Color fundus image
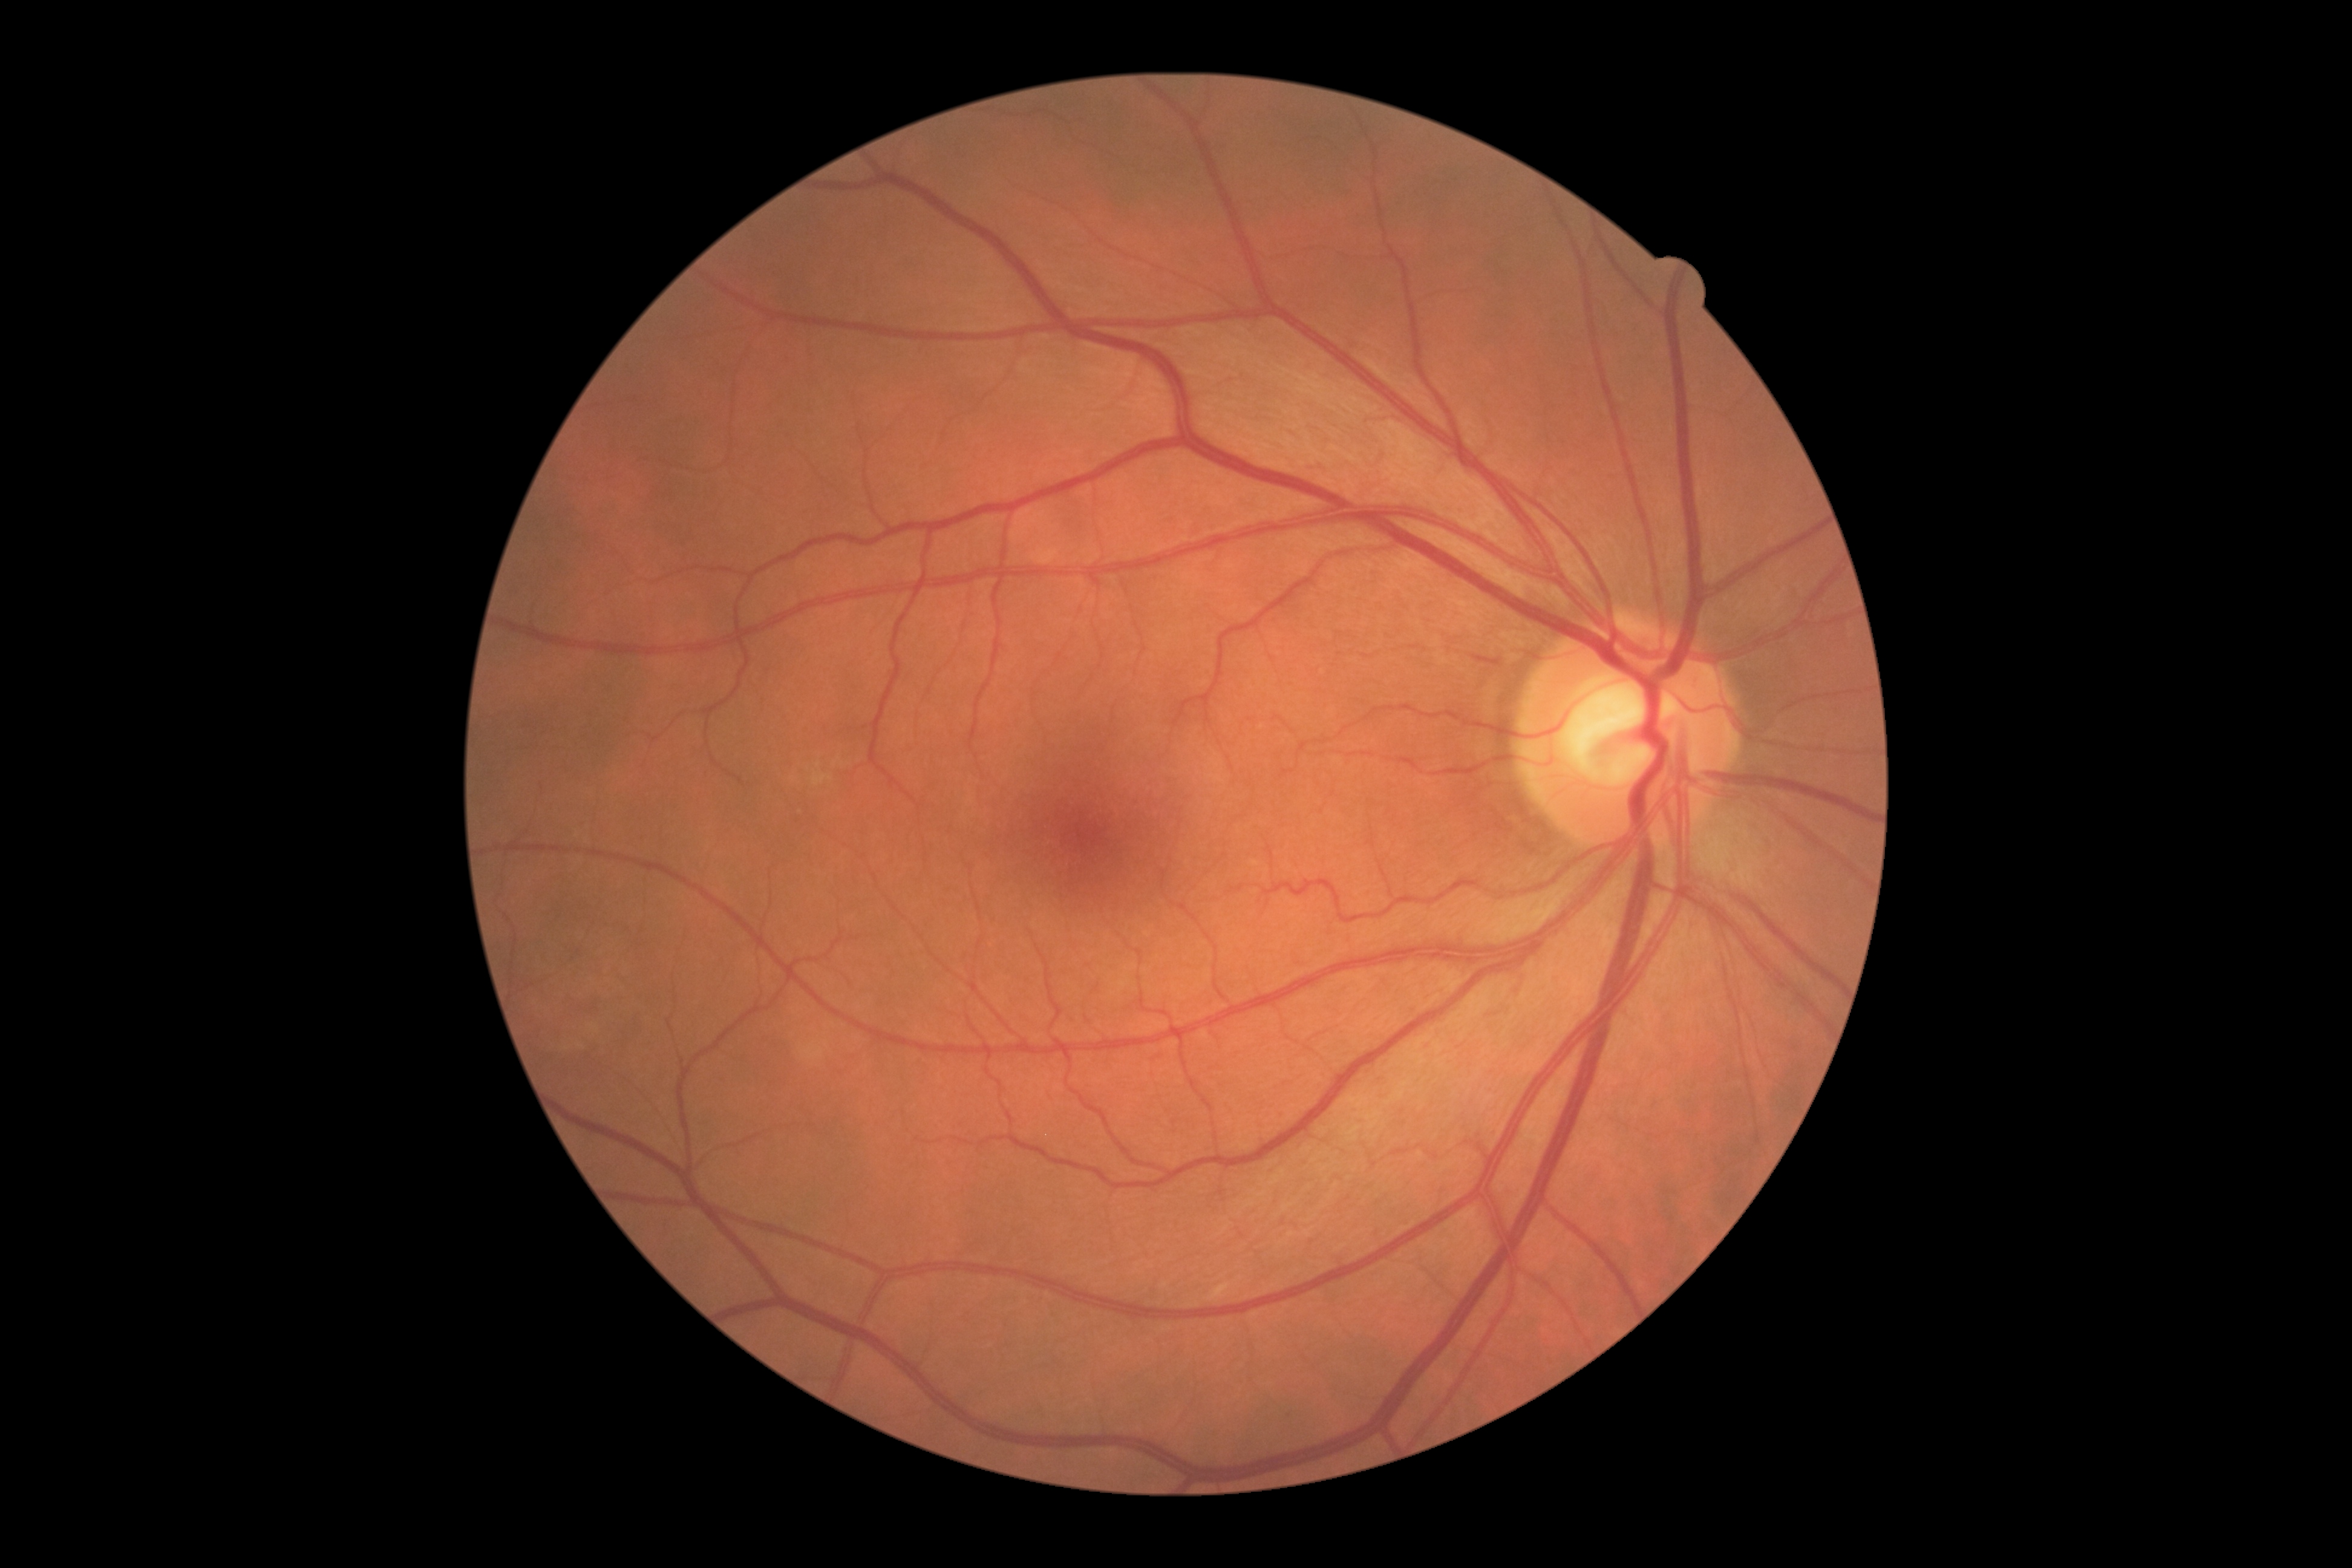

dr_grade: grade 0